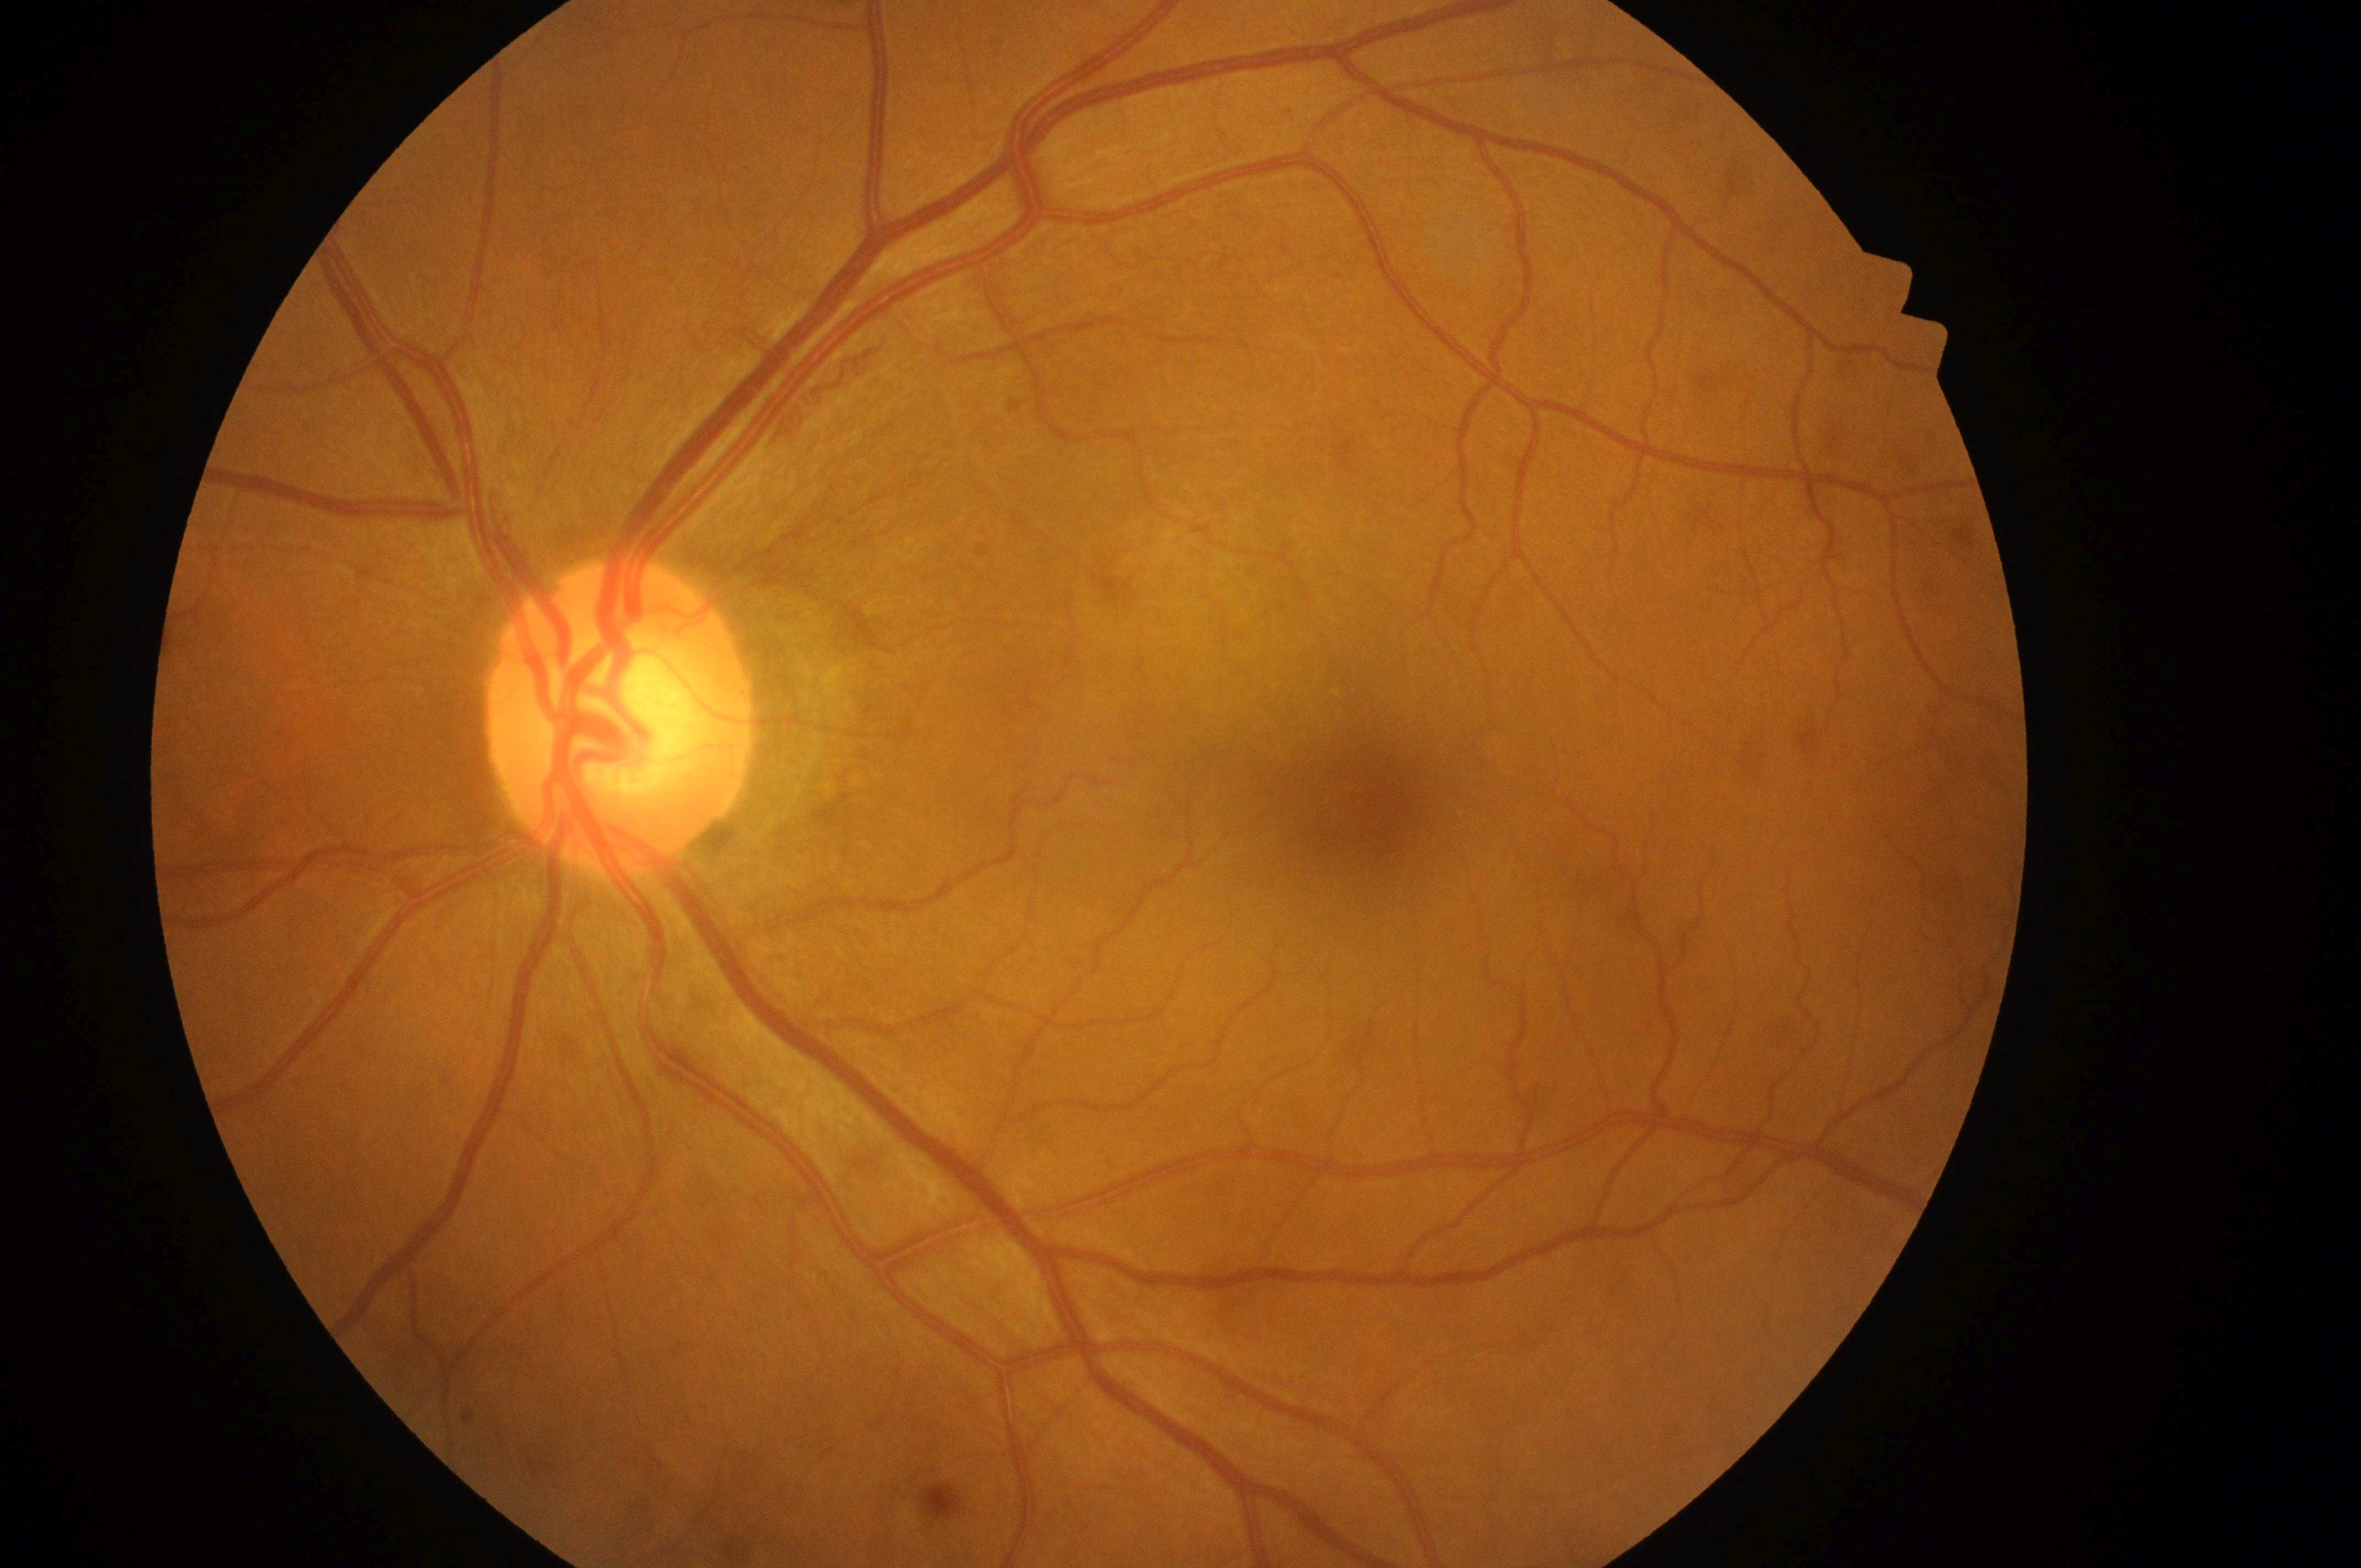 Diabetic retinopathy (DR) is grade 0 (no apparent retinopathy). Eye: left. Optic disk located at (x: 614, y: 727). Diabetic macular edema (DME) is no risk (grade 0). Fovea: (x: 1374, y: 806).